Wide-field fundus image from infant ROP screening — 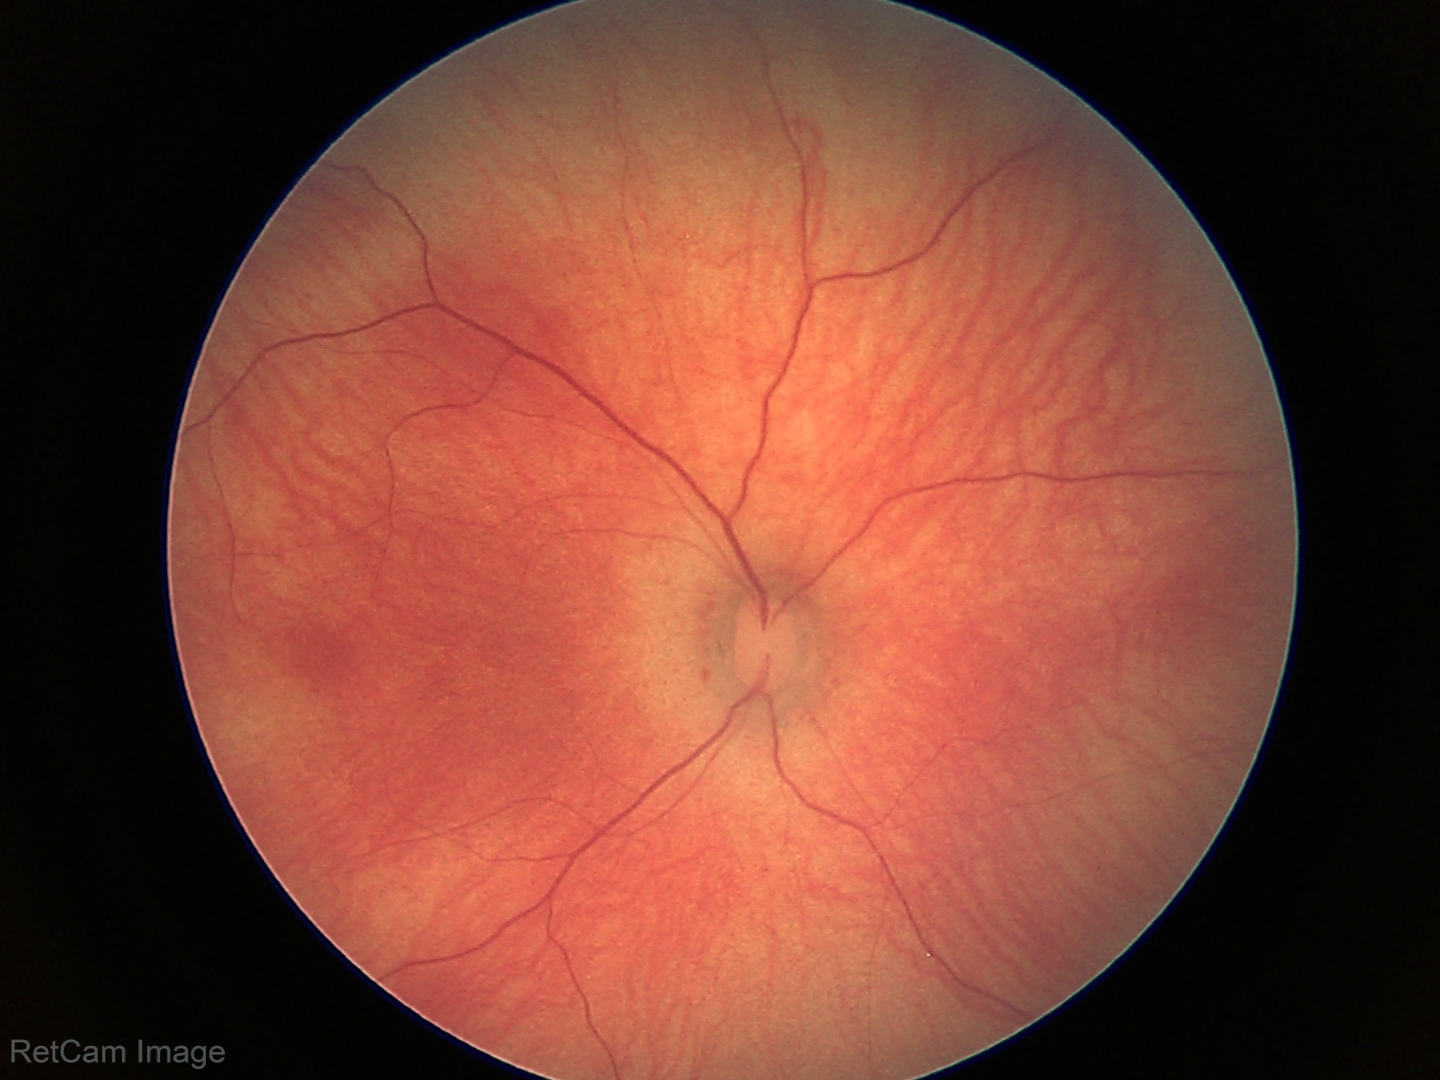
Physiological retinal appearance for postconceptual age.